Color fundus image:
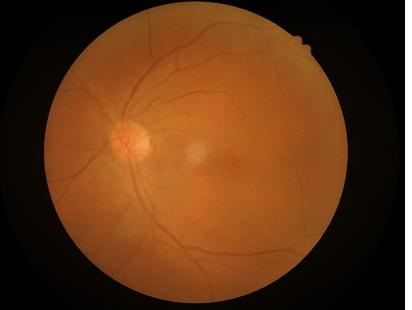 Image quality: sharpness: optic disc, vessels, and background in focus | contrast: wide intensity range, structures distinguishable | overall: good, gradable | illumination/color: good illumination and color balance.